Patient age: 71 years · axial length 23.3 mm · intraocular pressure (IOP) by non-contact tonometry: 14 mmHg · corneal thickness: 562 µm.
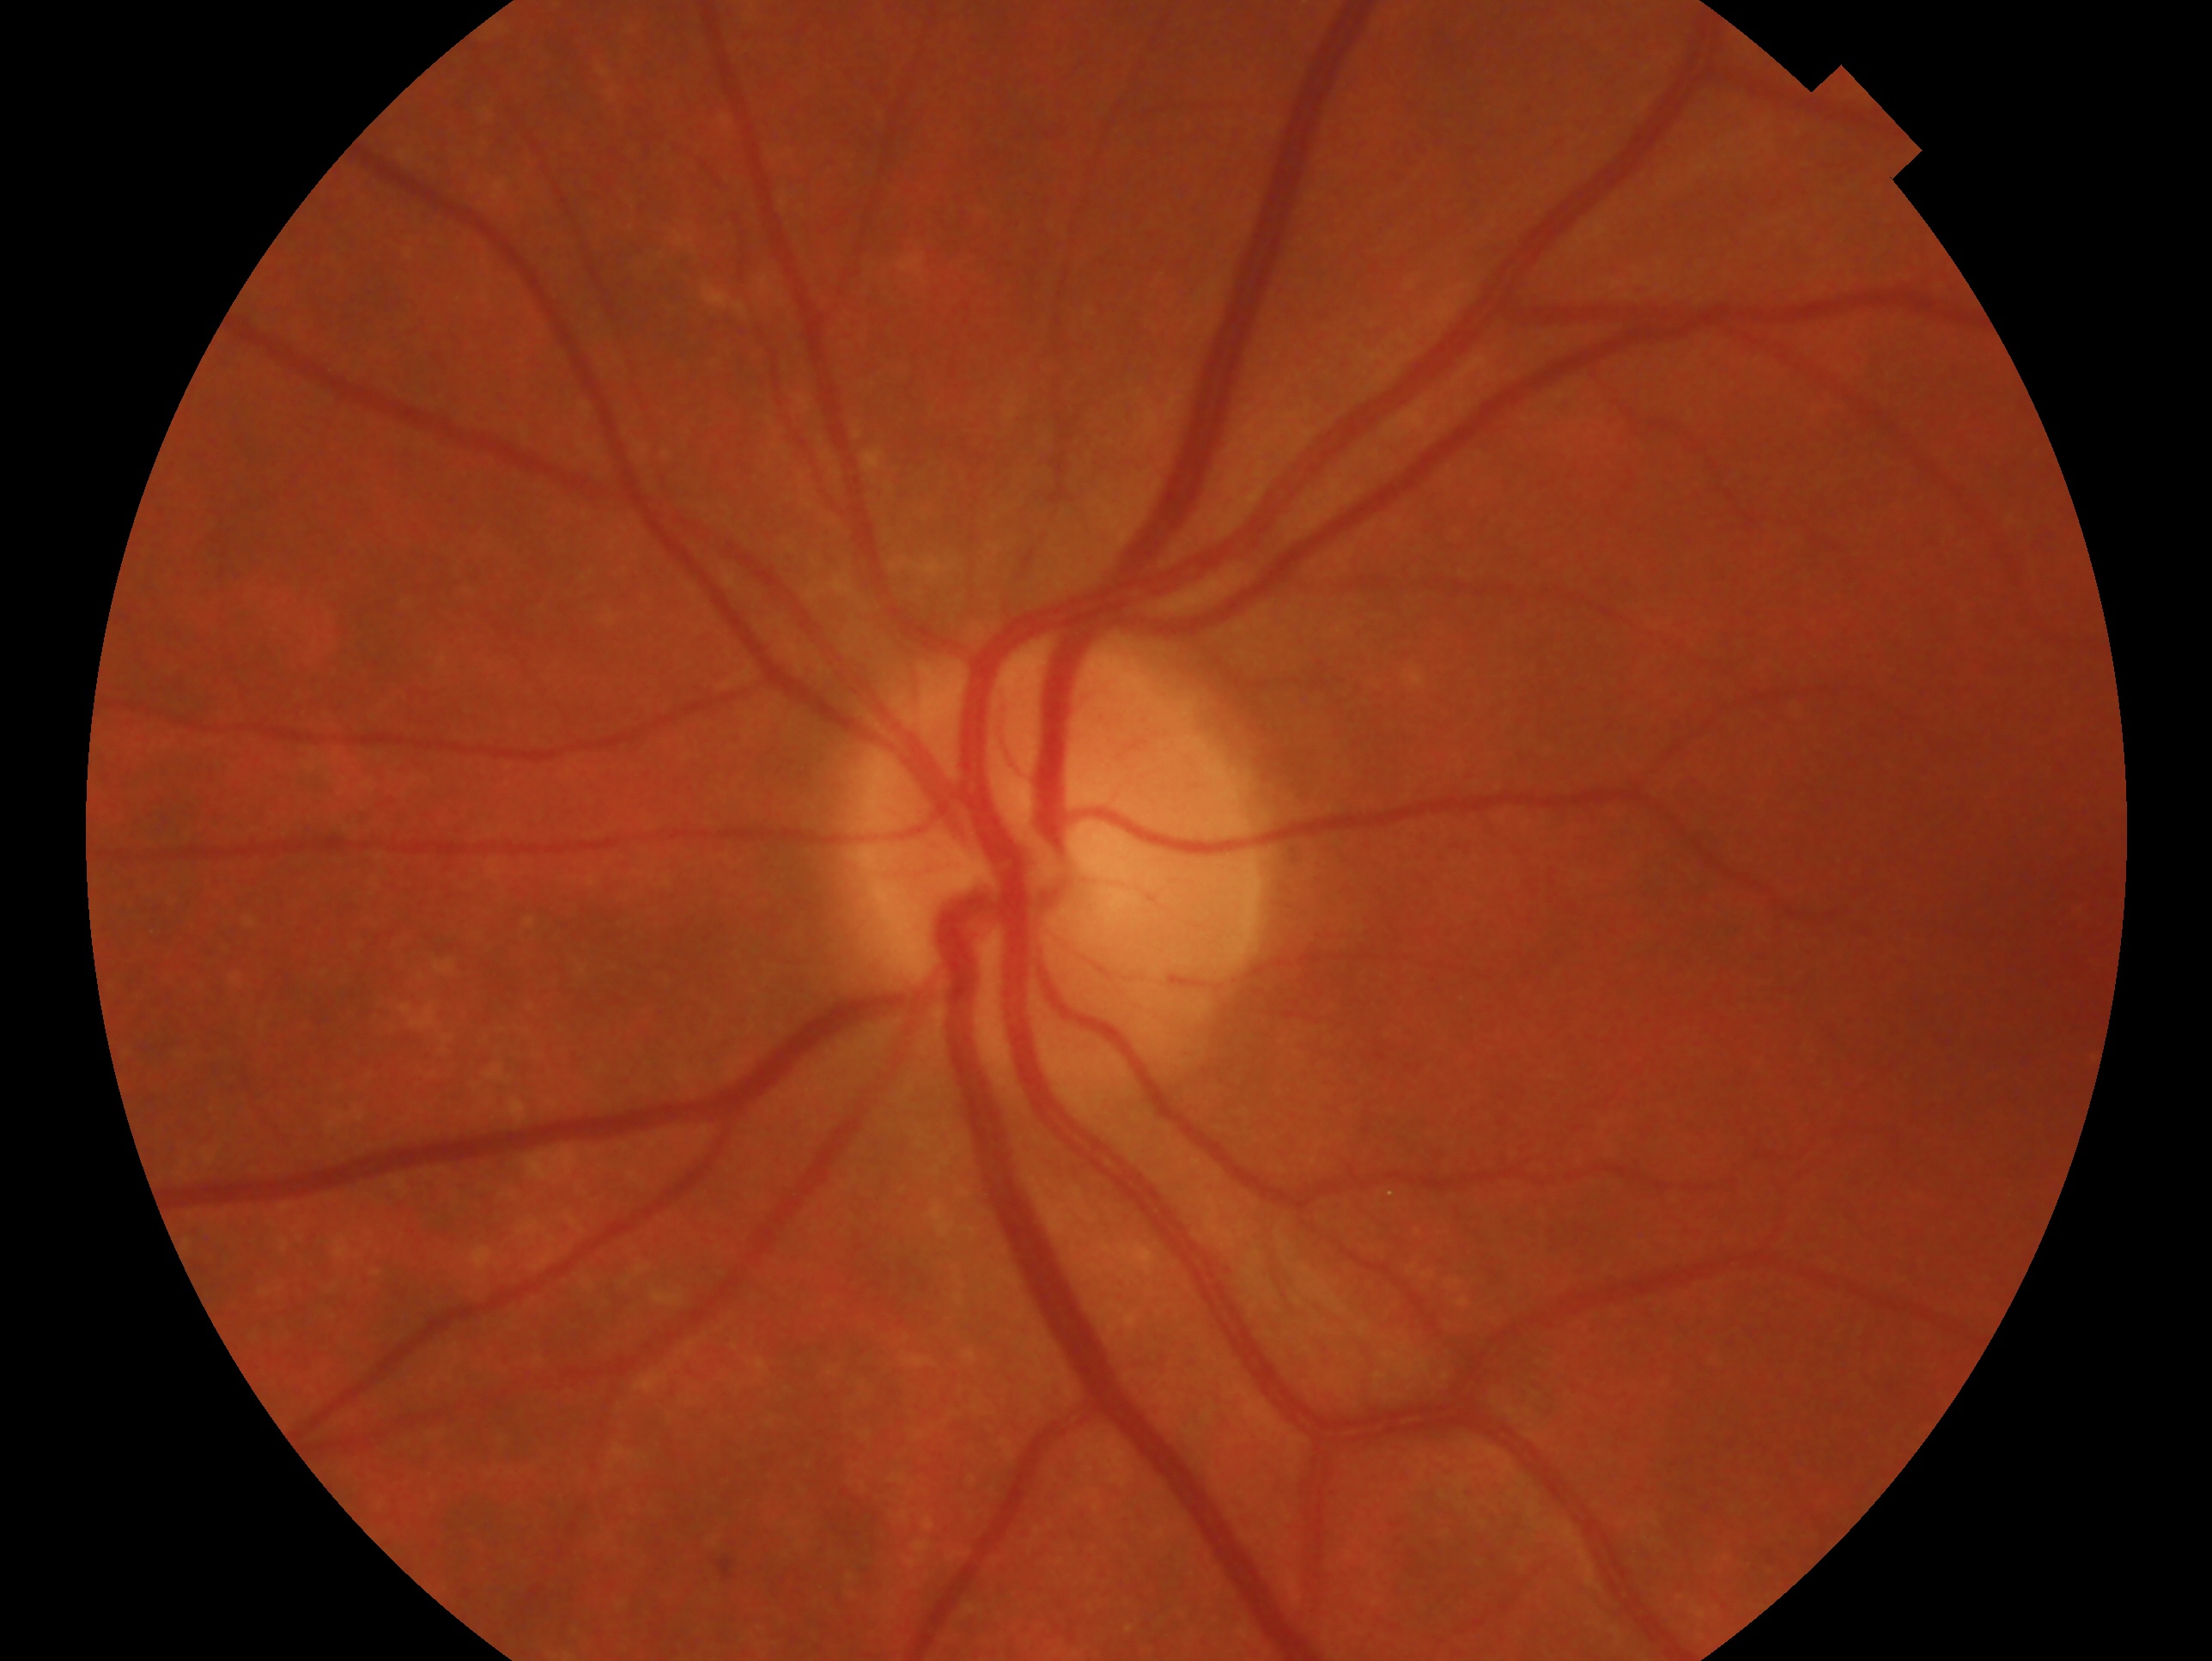
impression: negative for glaucoma | eye: OS.